Color fundus photograph from a handheld portable camera; 2212 x 1659 pixels:
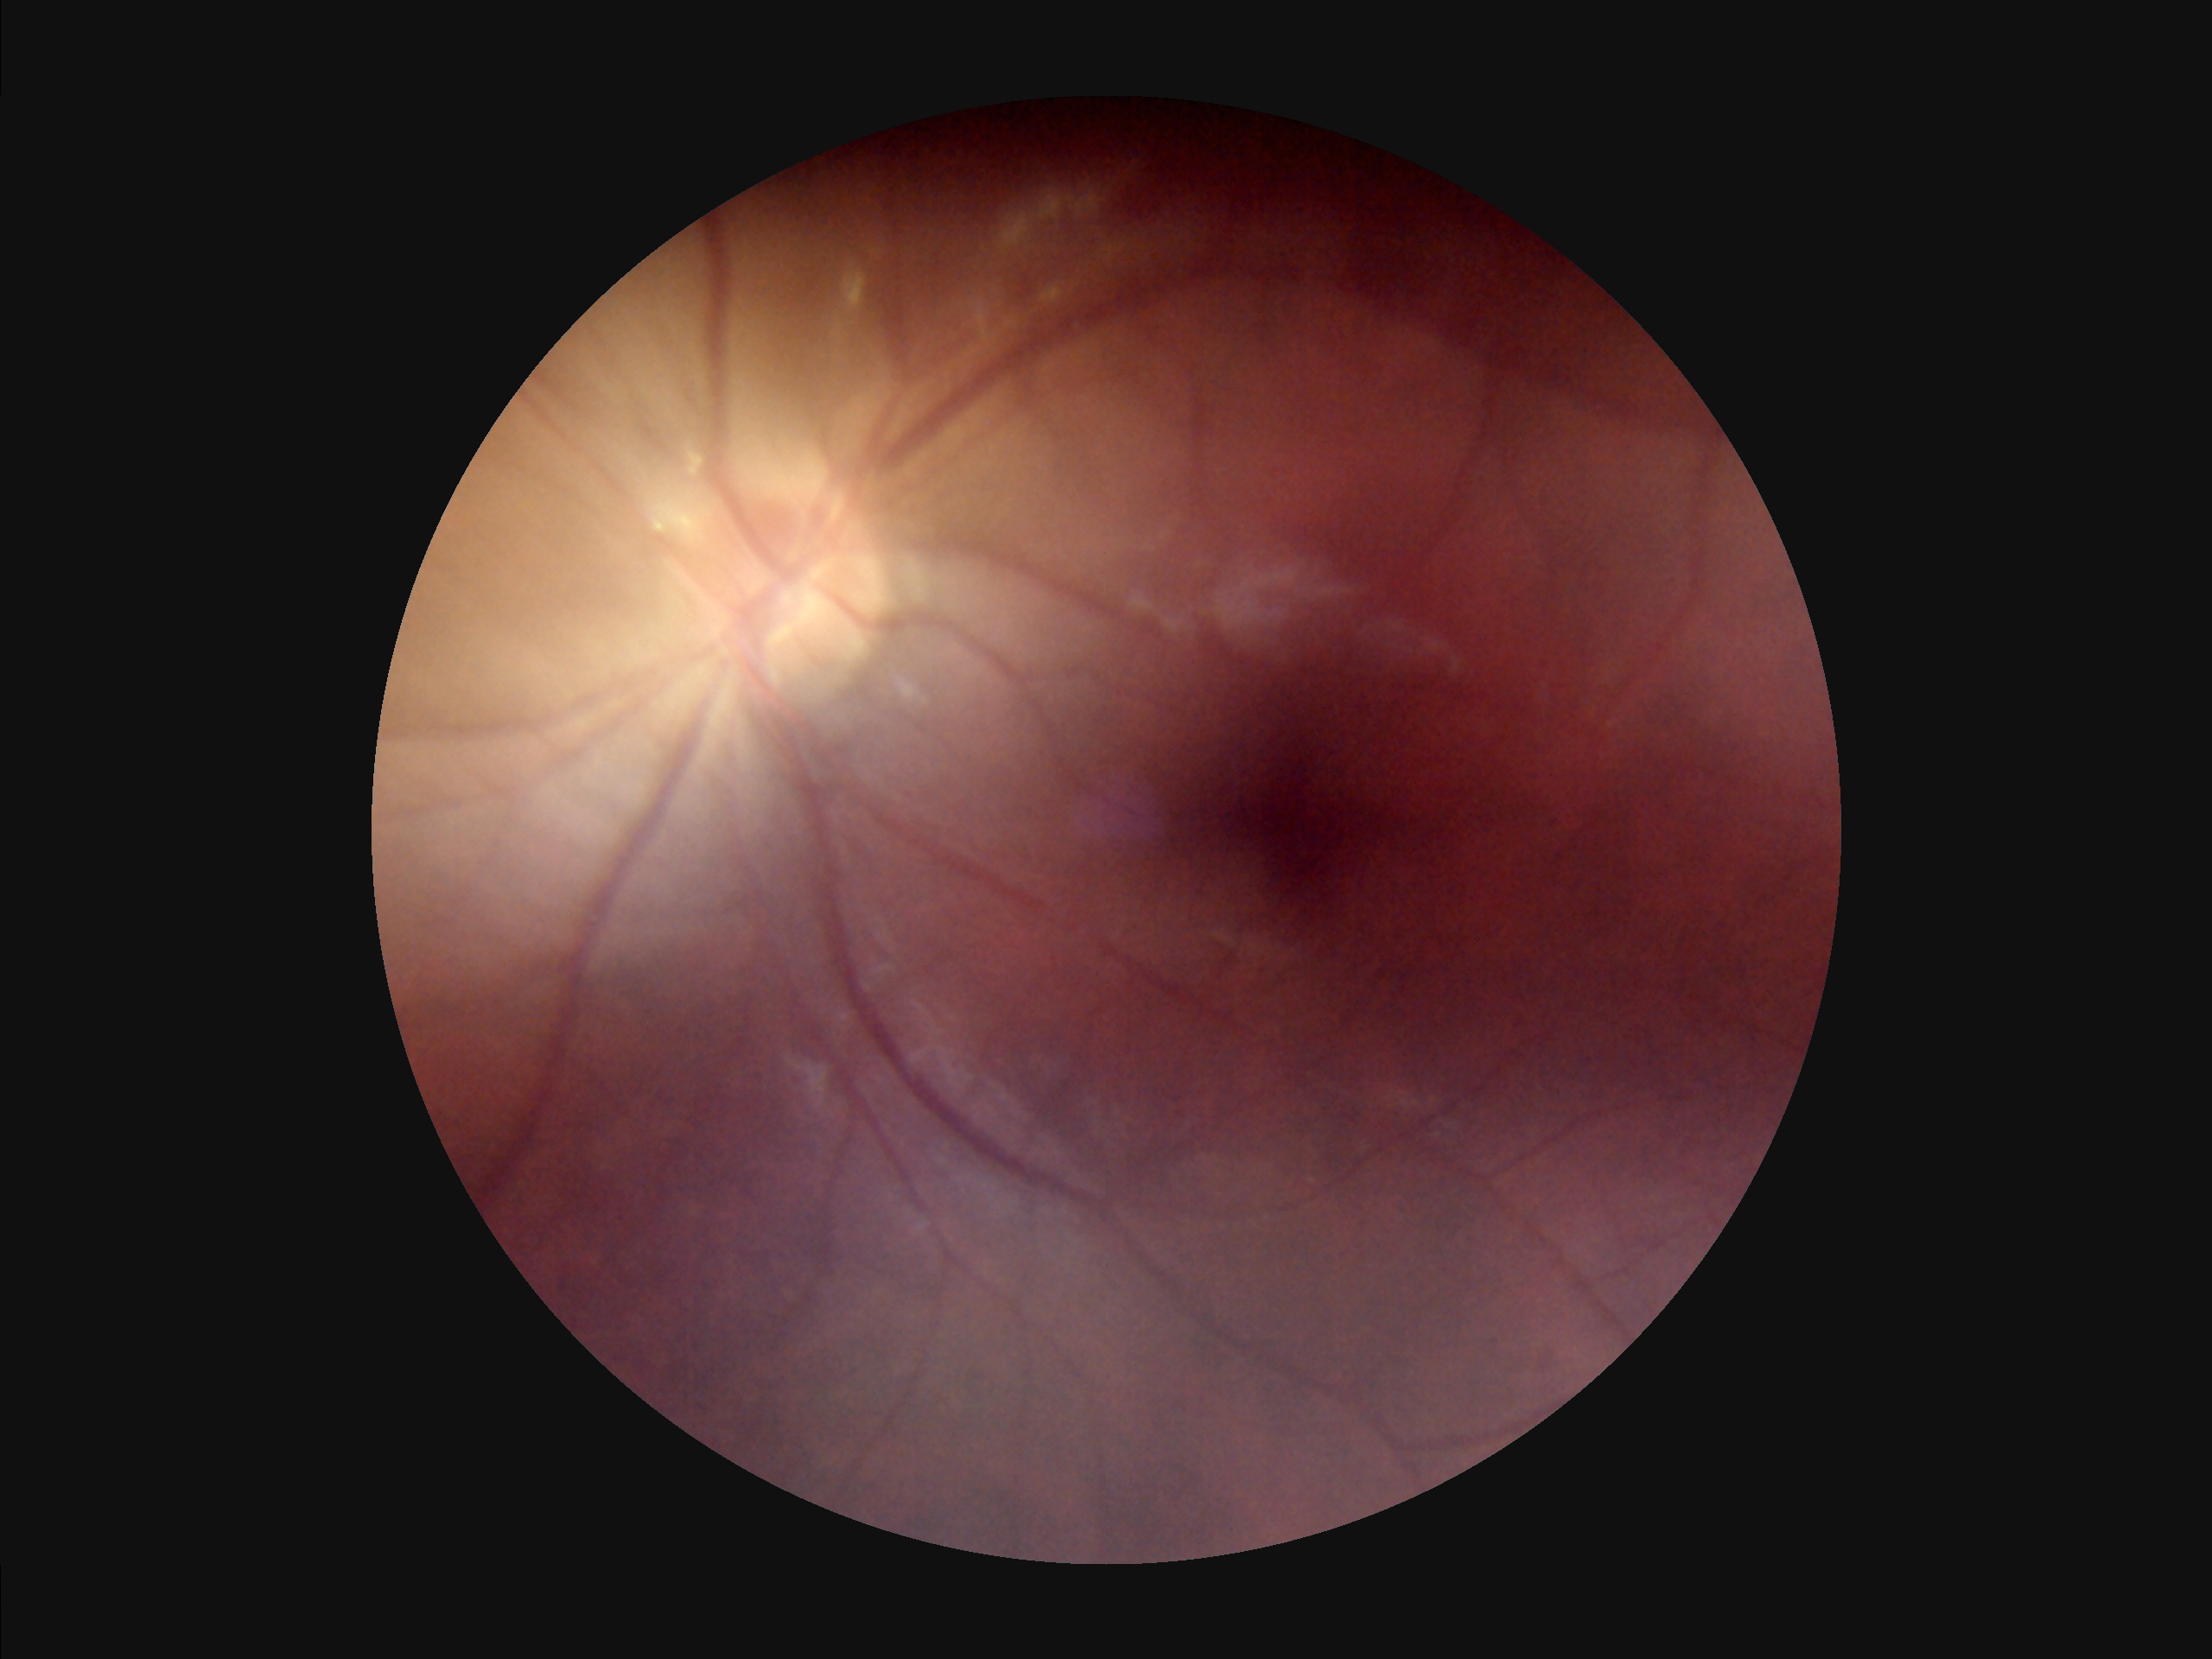
illumination: poor
contrast: low
overall_quality: low
clarity: blurry